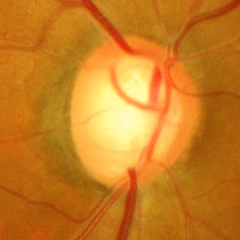
Color fundus photograph showing advanced-stage glaucoma. (Criteria: near-total cupping of the optic nerve head, with or without severe visual field loss within the central 10 degrees of fixation.)